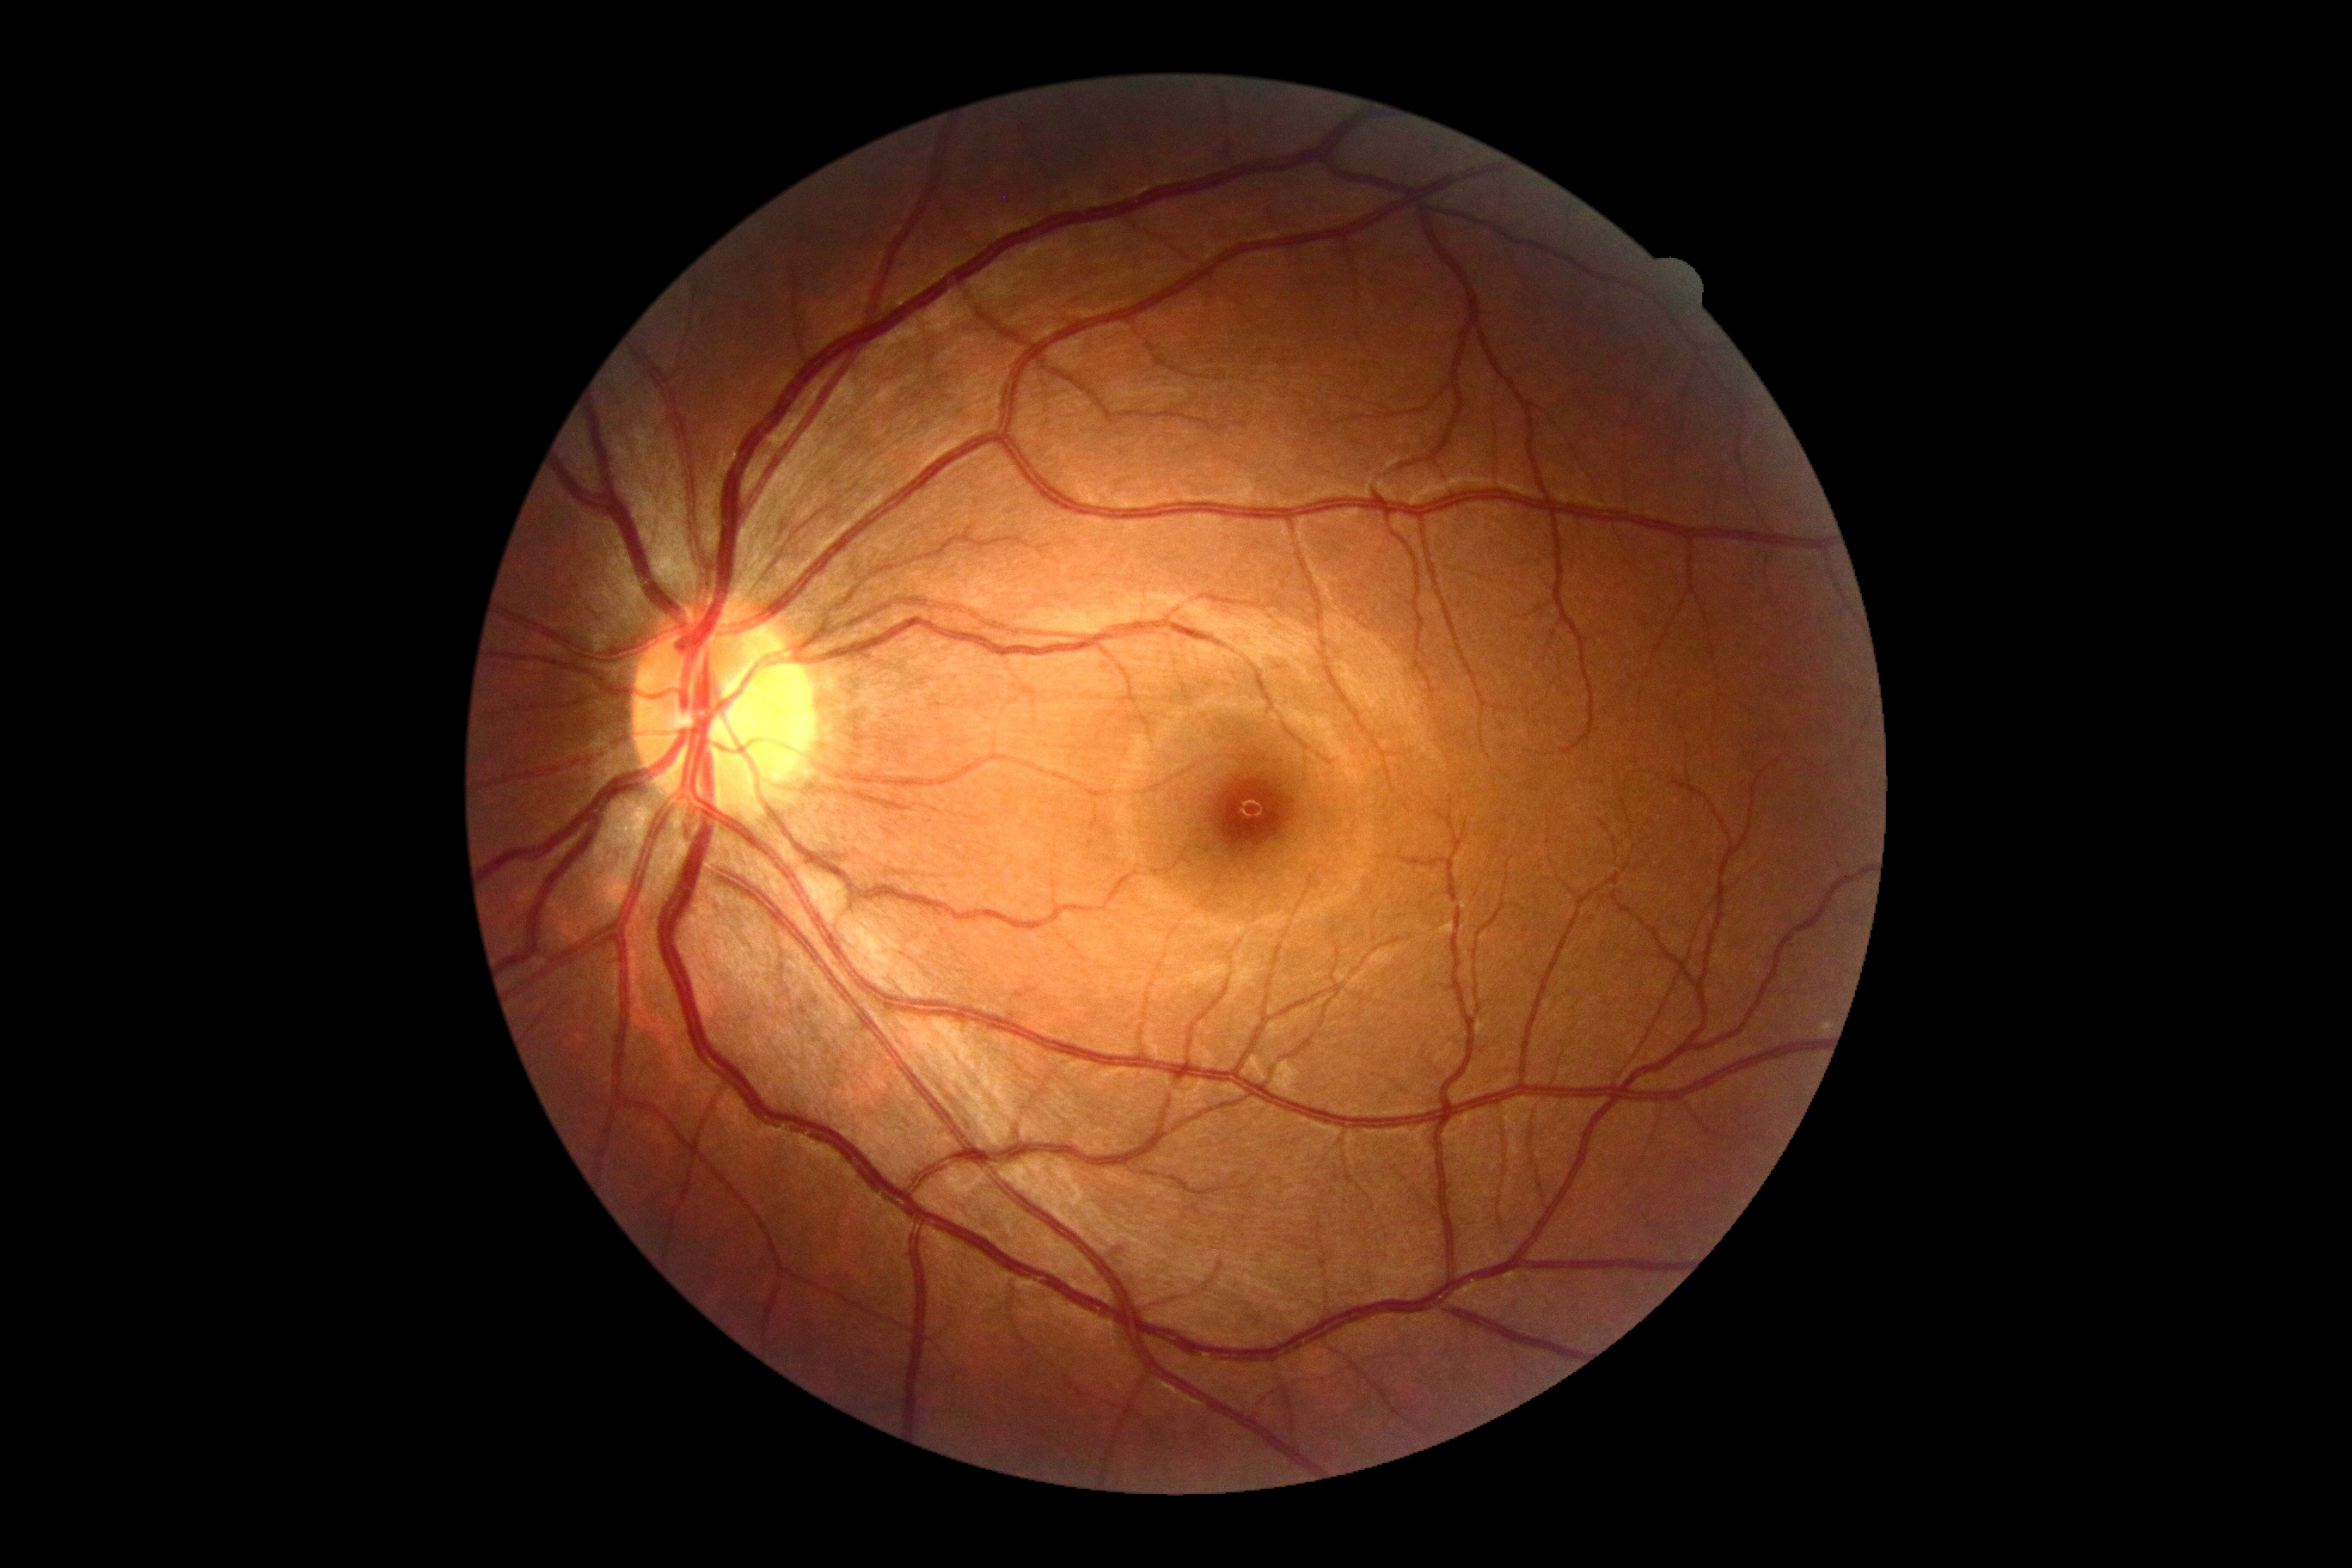 DR severity: grade 0 (no apparent retinopathy).